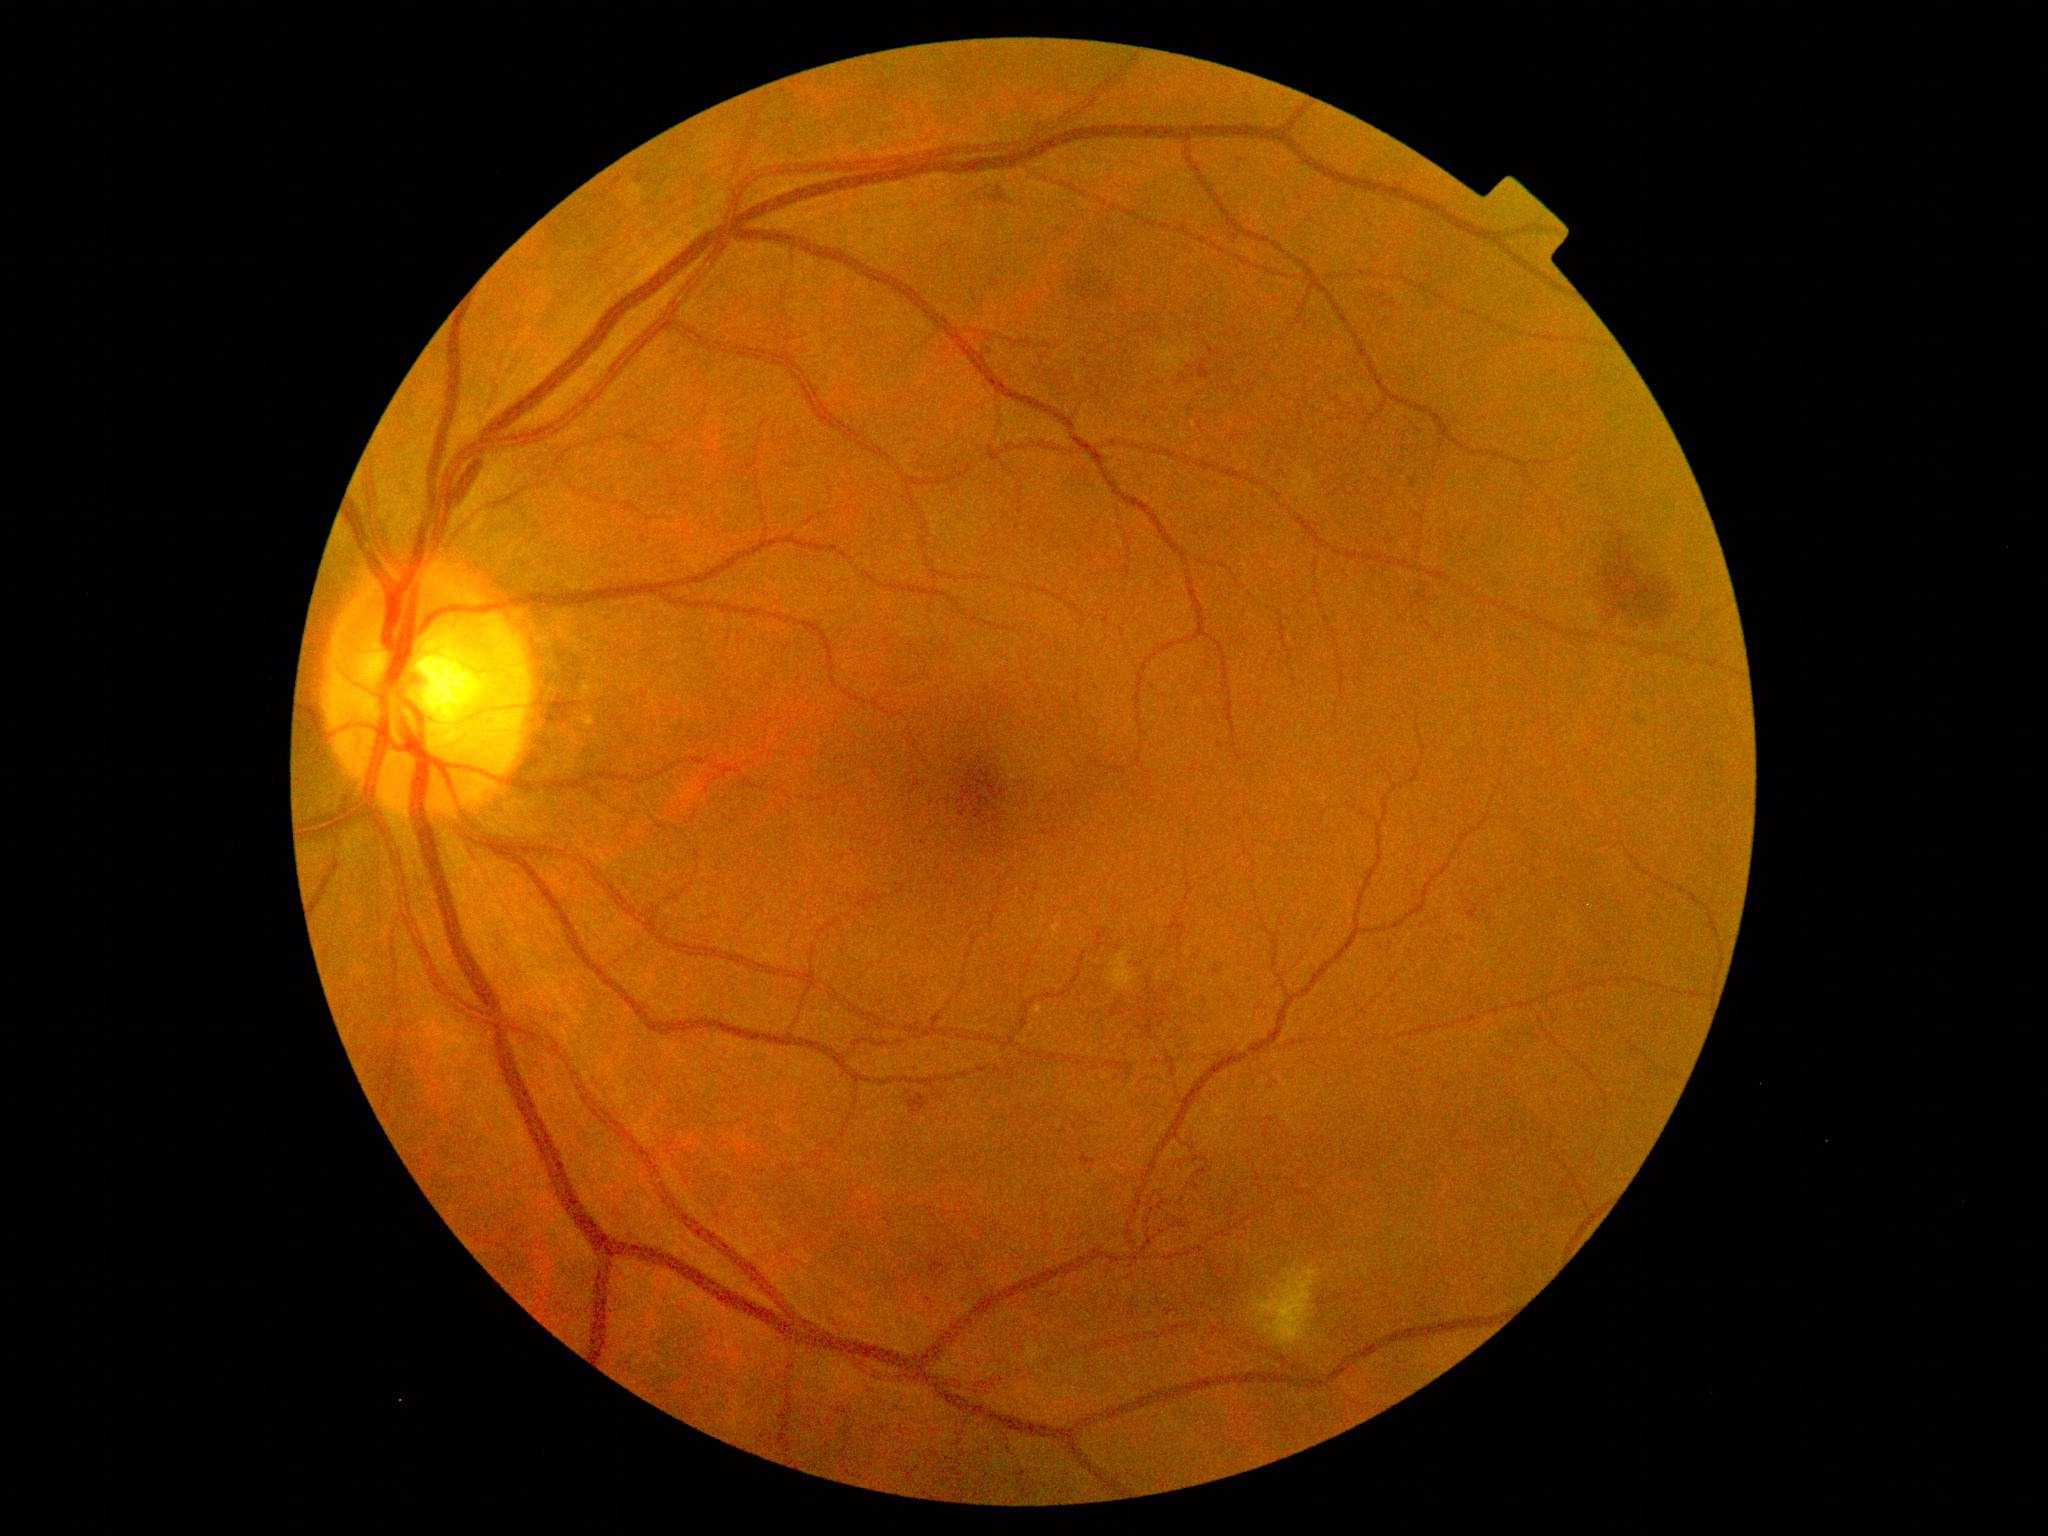 Diabetic retinopathy (DR) is 2/4. Disease class: non-proliferative diabetic retinopathy.